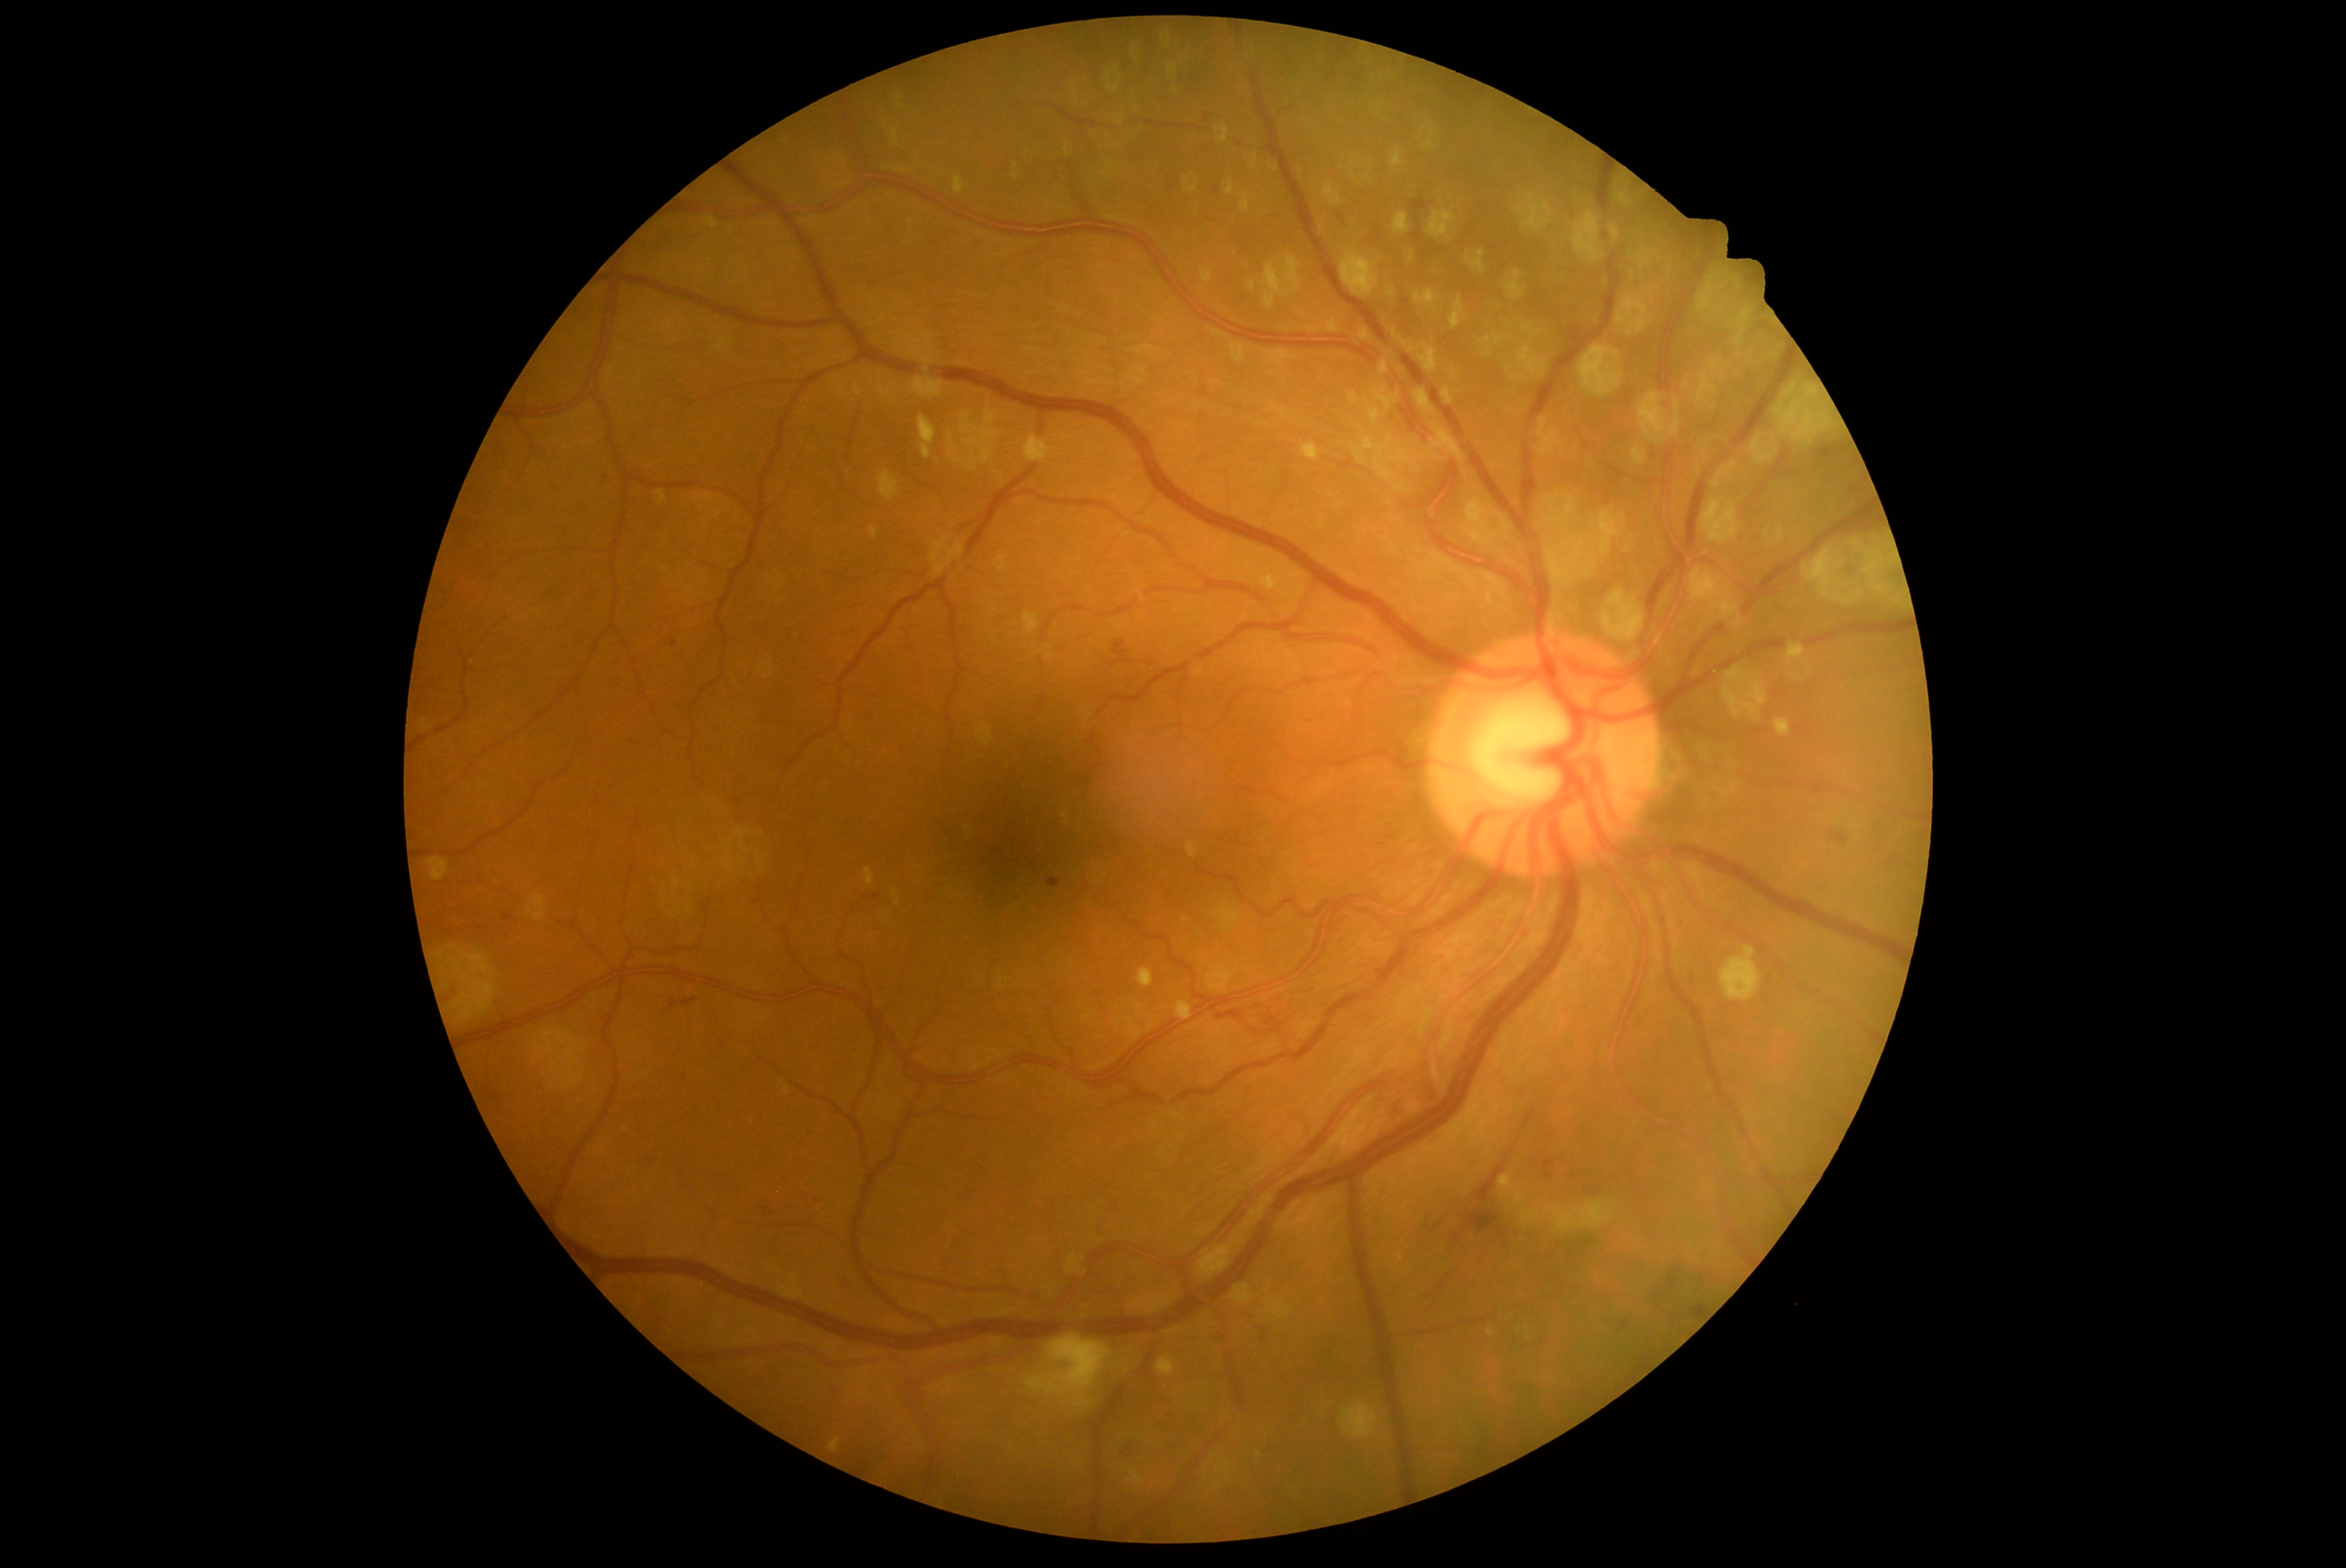 Diabetic retinopathy (DR): 2.